Pediatric retinal photograph (wide-field).
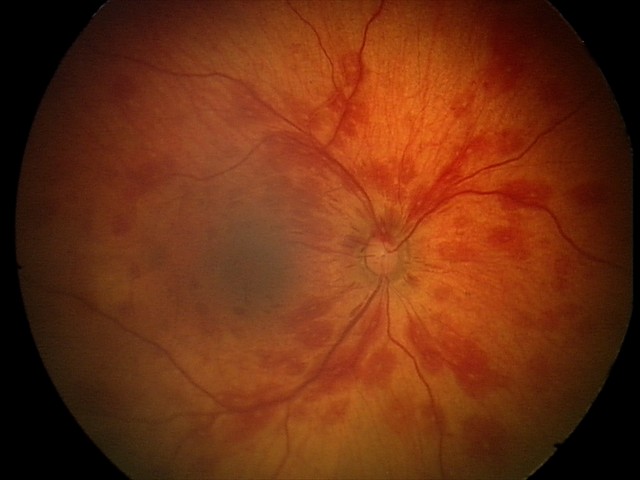 Q: What is the screening diagnosis?
A: retinal hemorrhages